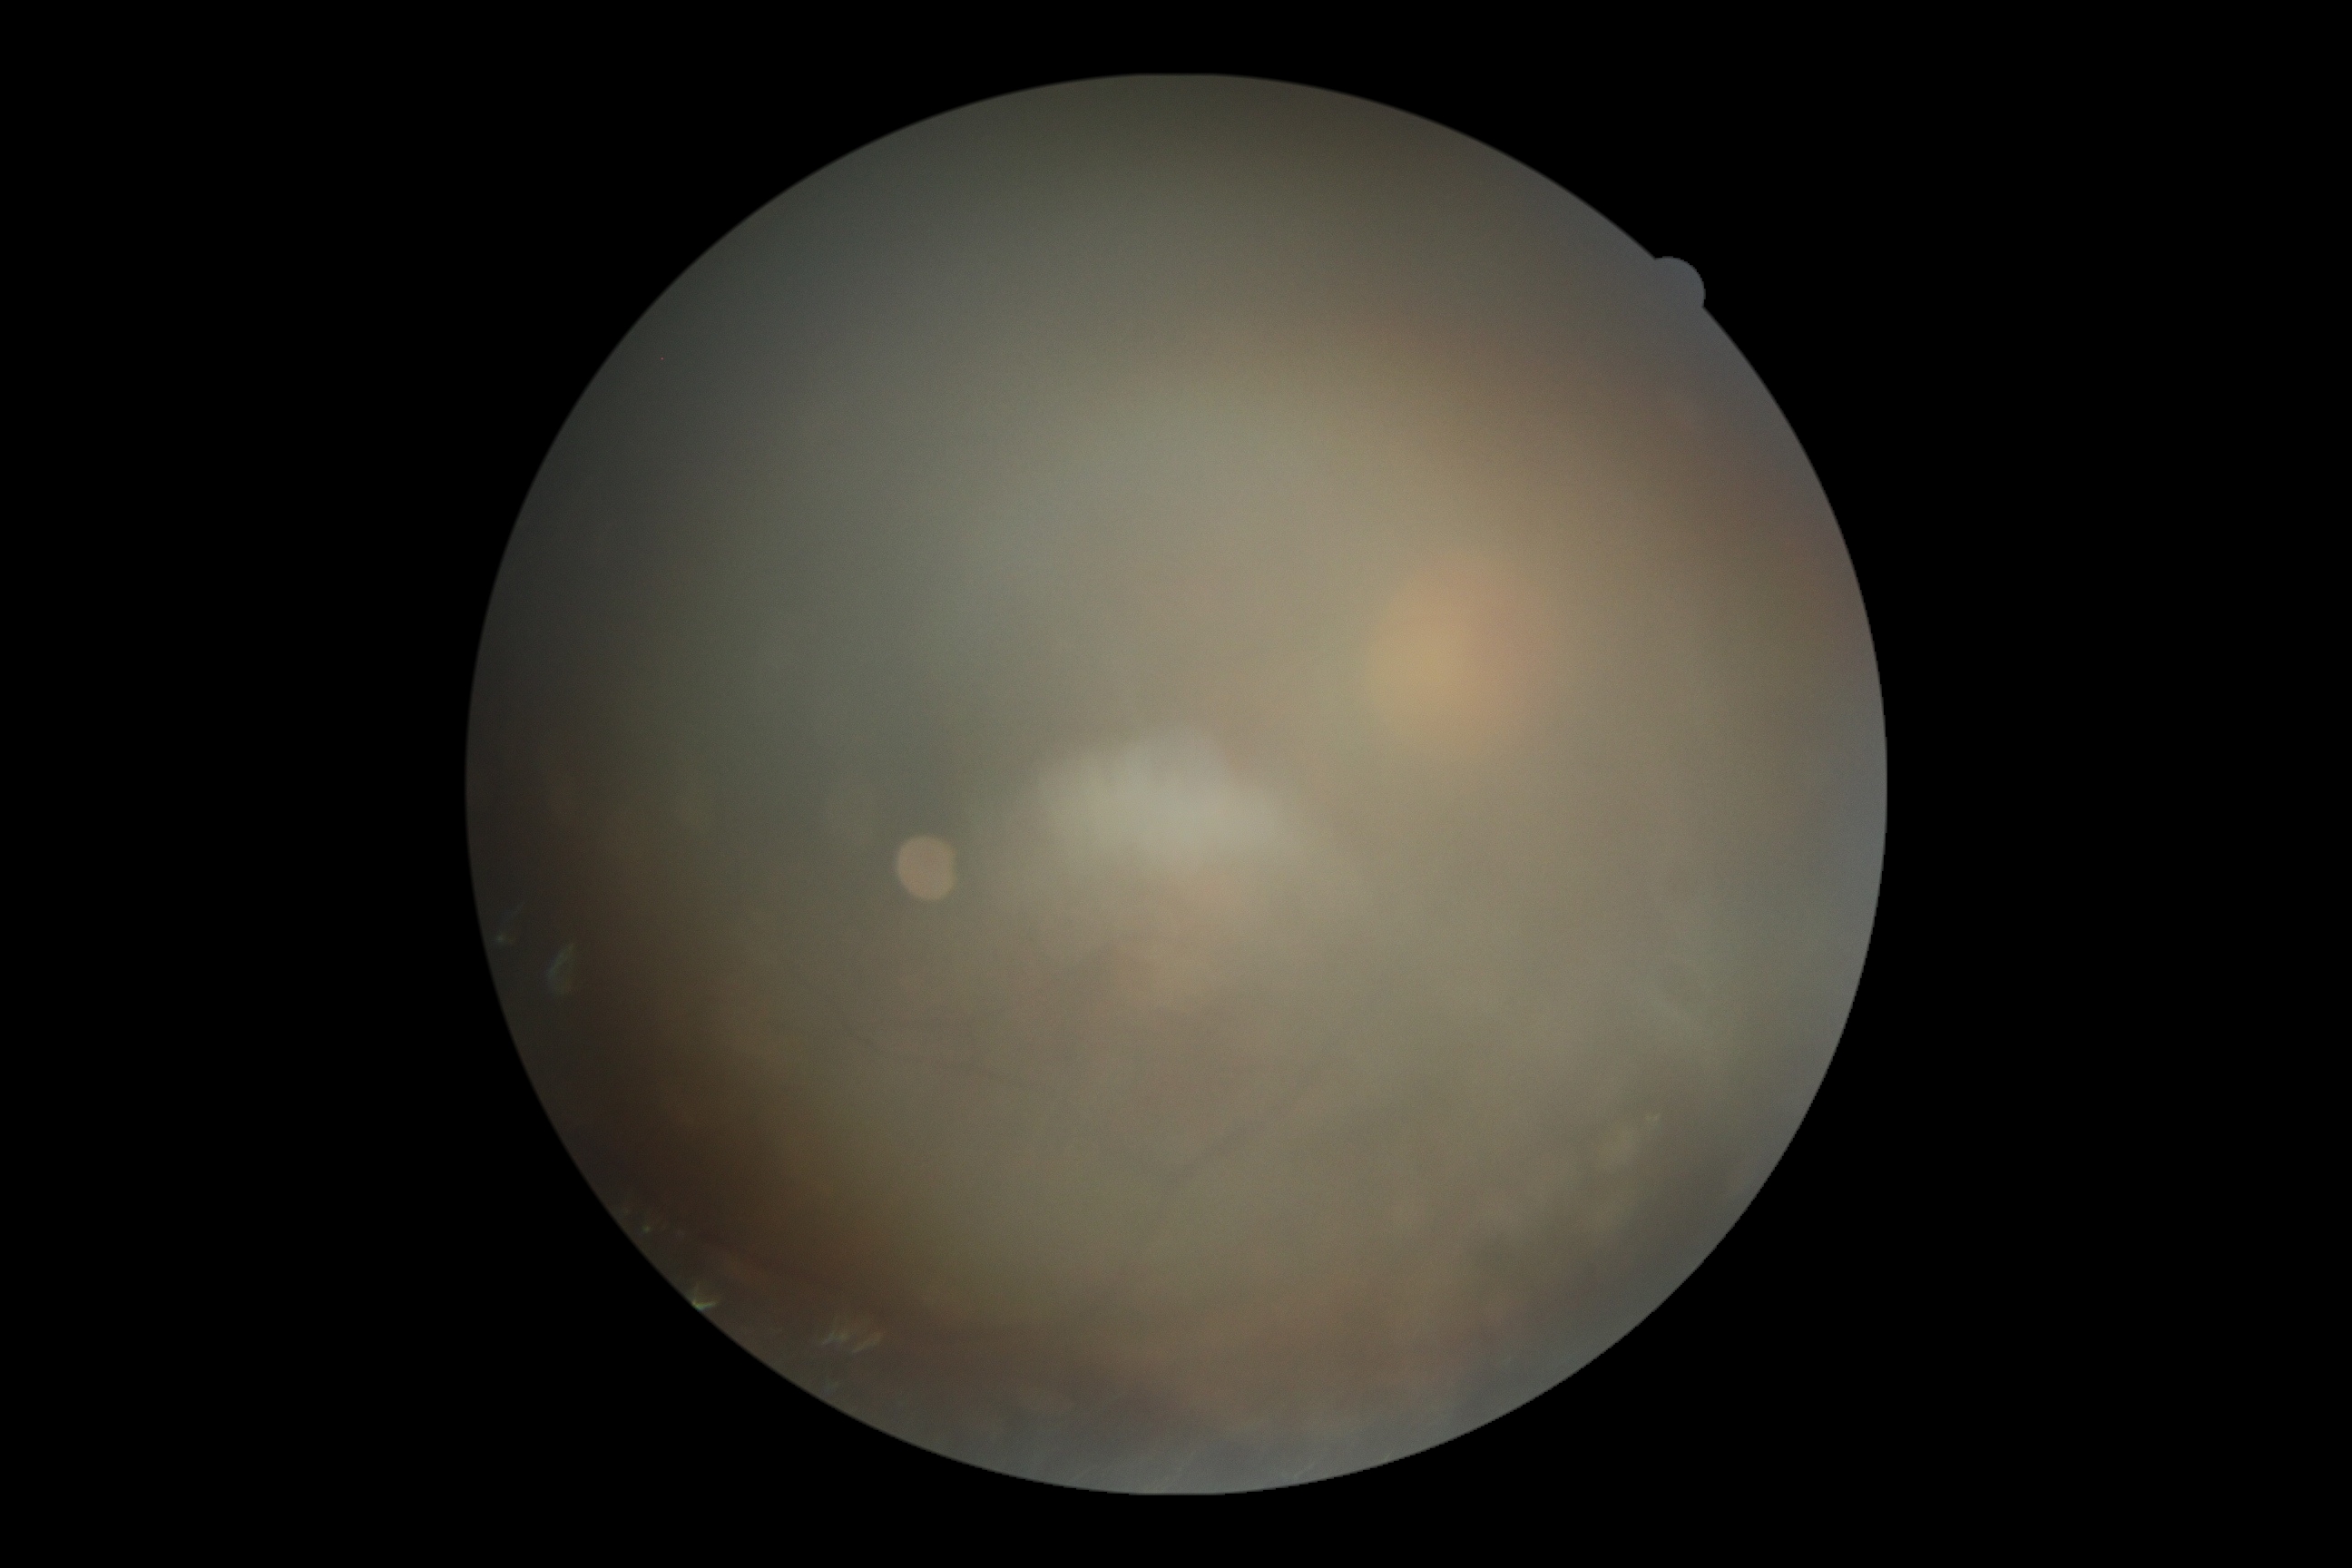

DR grade: ungradable due to poor image quality.